Graded on the modified Davis scale:
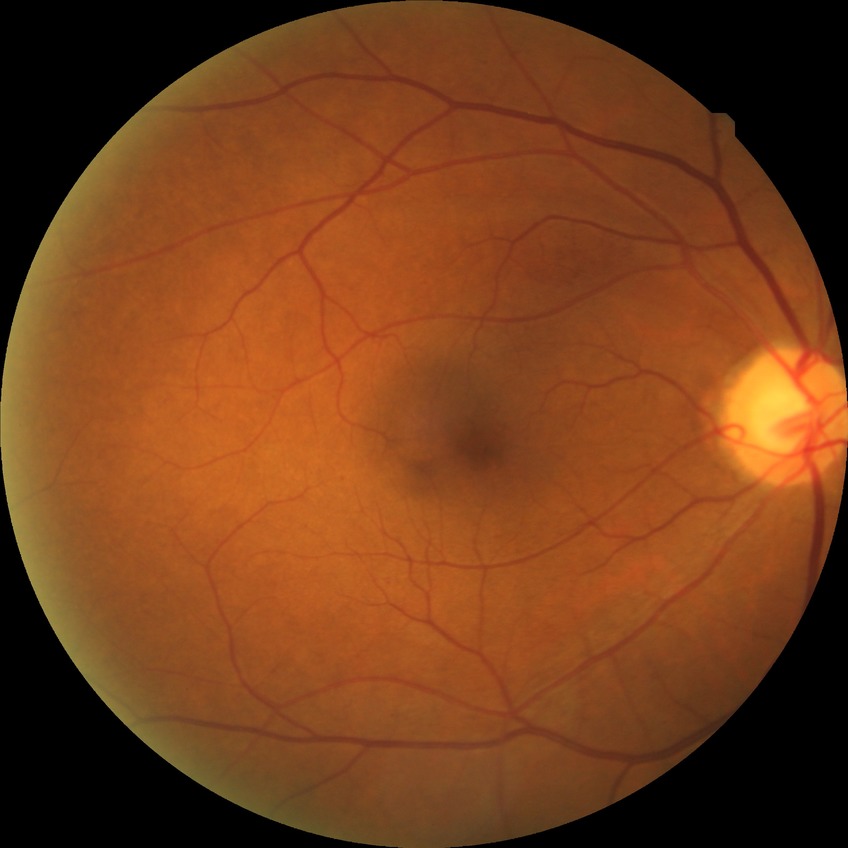
diabetic retinopathy (DR) = SDR (simple diabetic retinopathy).